Graded on the modified Davis scale; CFP; FOV: 45 degrees; no pharmacologic dilation:
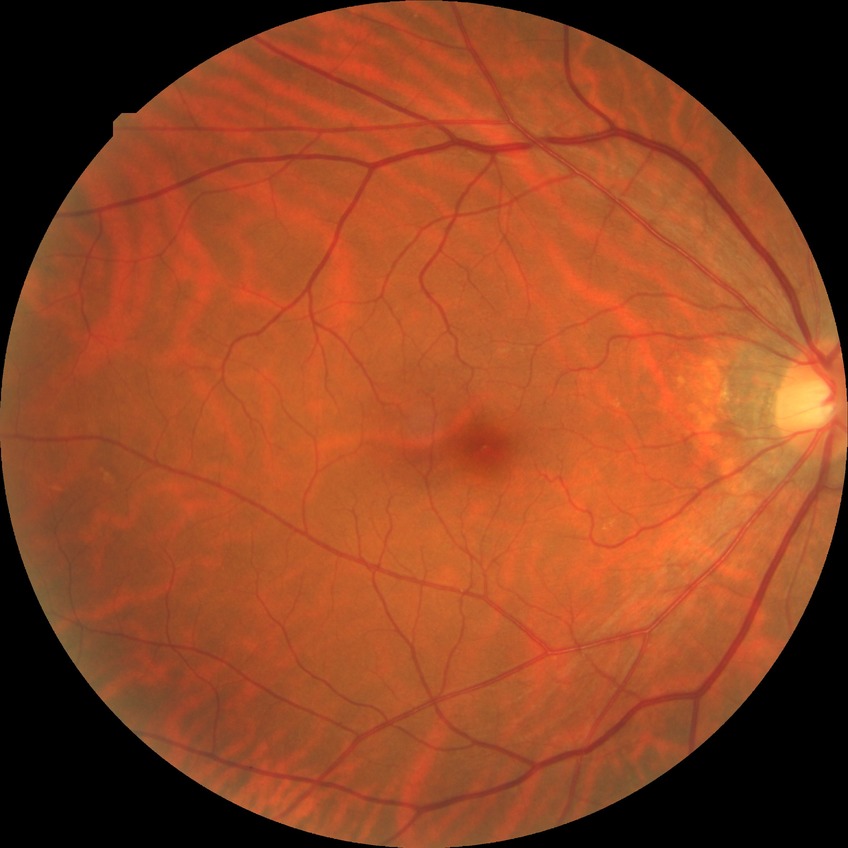 Diabetic retinopathy (DR) is NDR (no diabetic retinopathy).